Wide-field fundus image from infant ROP screening: 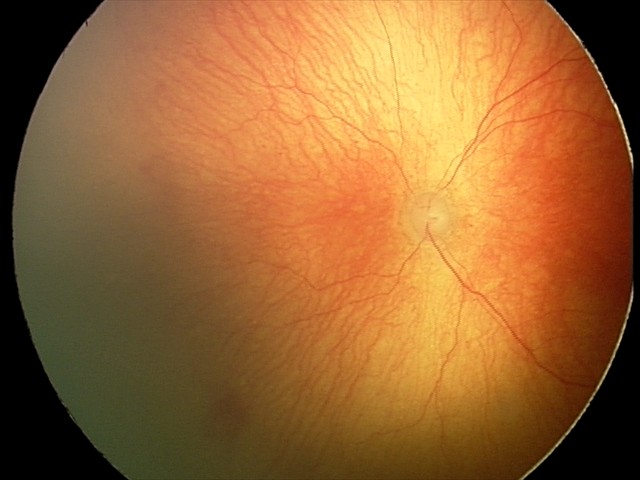

Screening: aggressive ROP (A-ROP) | plus disease.